ONH-centered crop from a color fundus image; camera: Topcon TRC
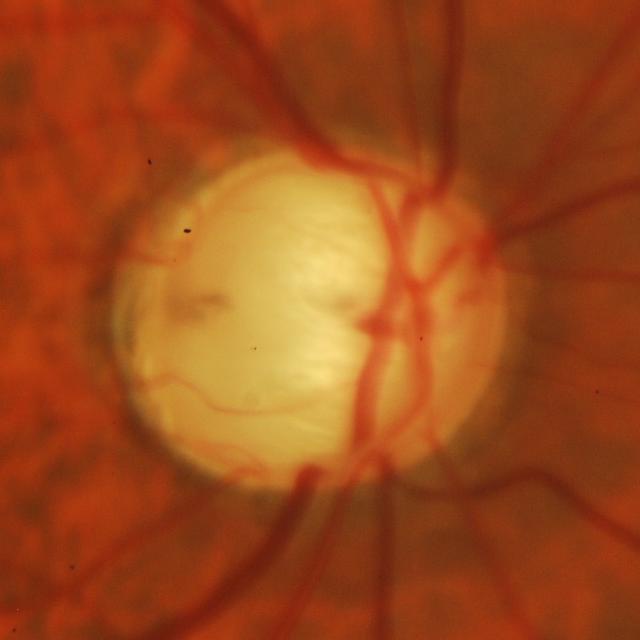
Glaucomatous optic neuropathy is present. Assessment: glaucomatous changes.